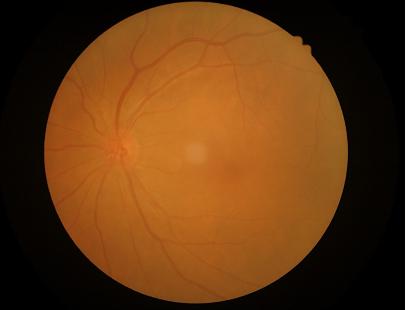

Illumination is even. Out of focus; structures are indistinct. Overall quality is poor; the image is difficult to grade.